Captured with the Clarity RetCam 3 (130° field of view) · pediatric wide-field fundus photograph · image size 640x480:
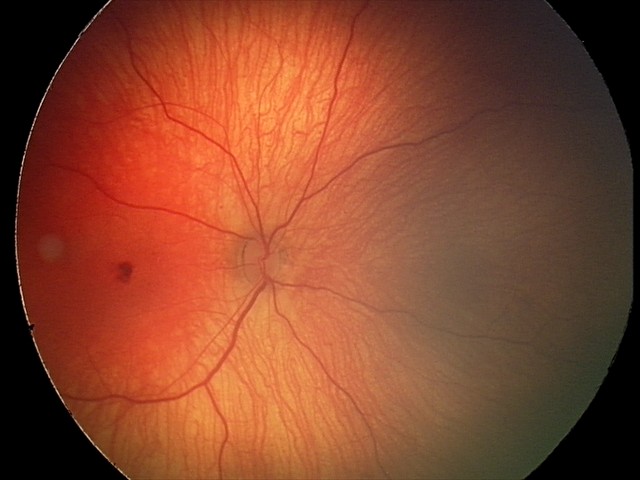 Screening series with retinal hemorrhages.